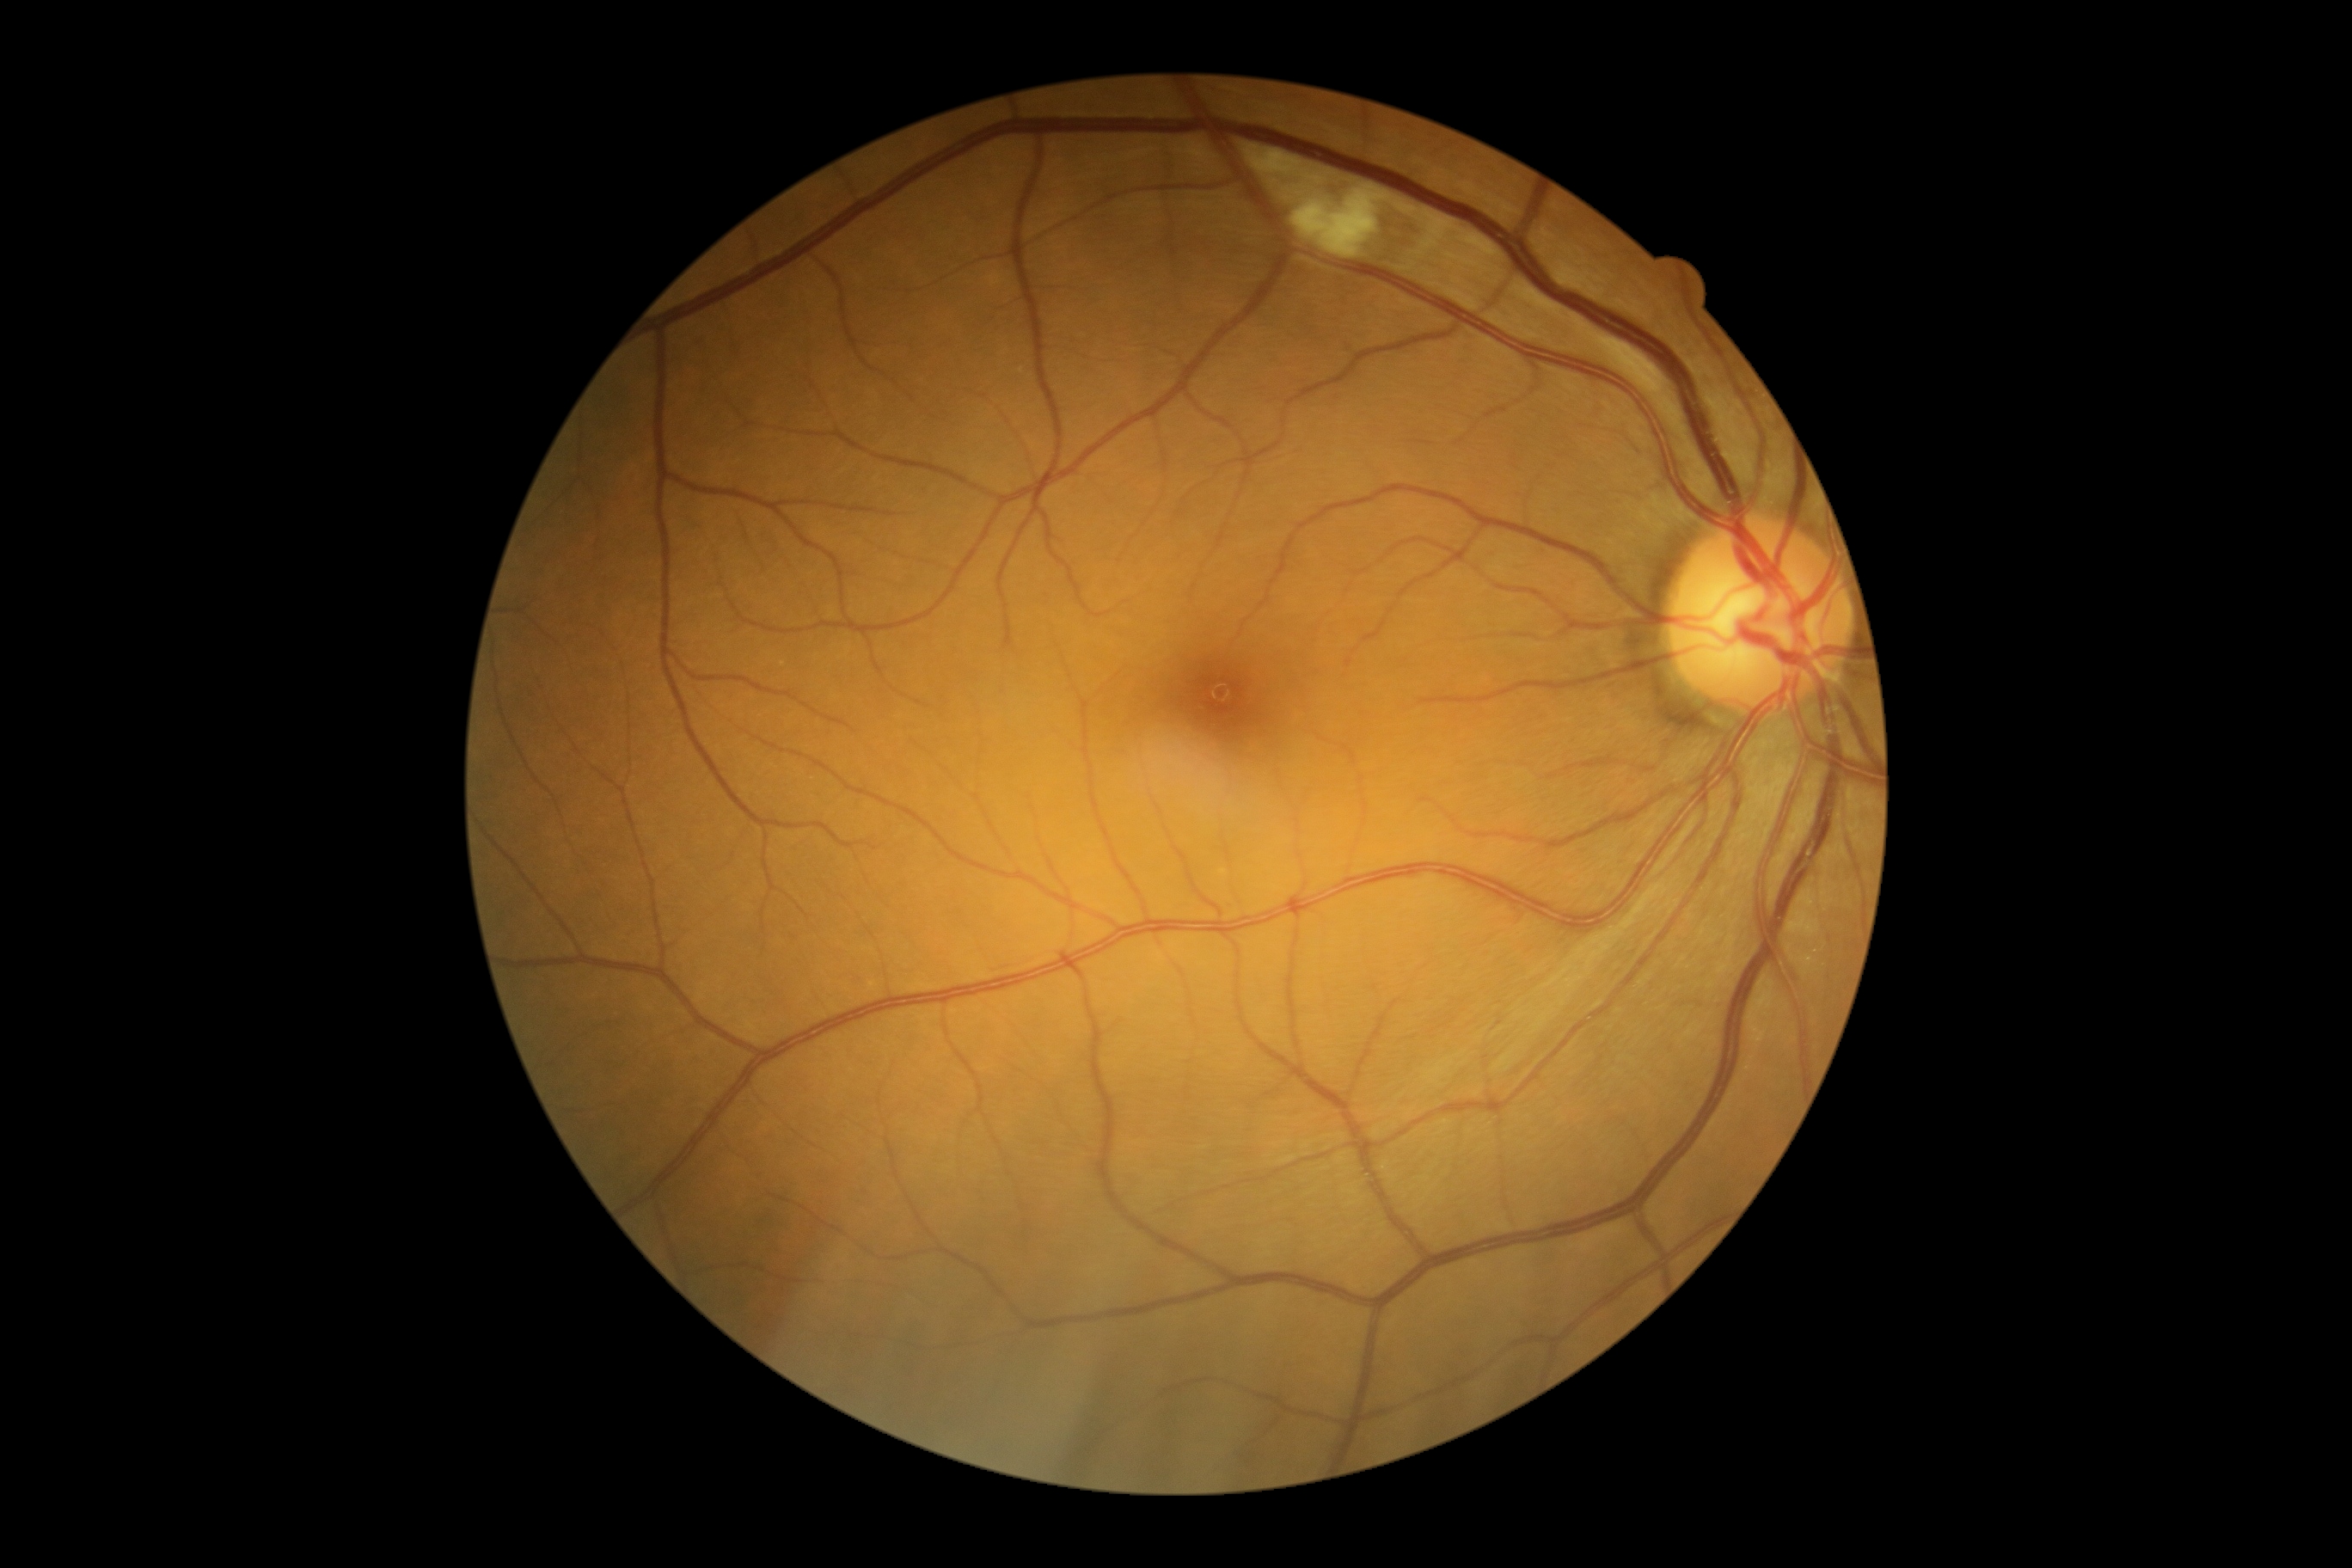

Findings:
– diabetic retinopathy (DR) — grade 2 — more than just microaneurysms but less than severe NPDR